45° field of view: 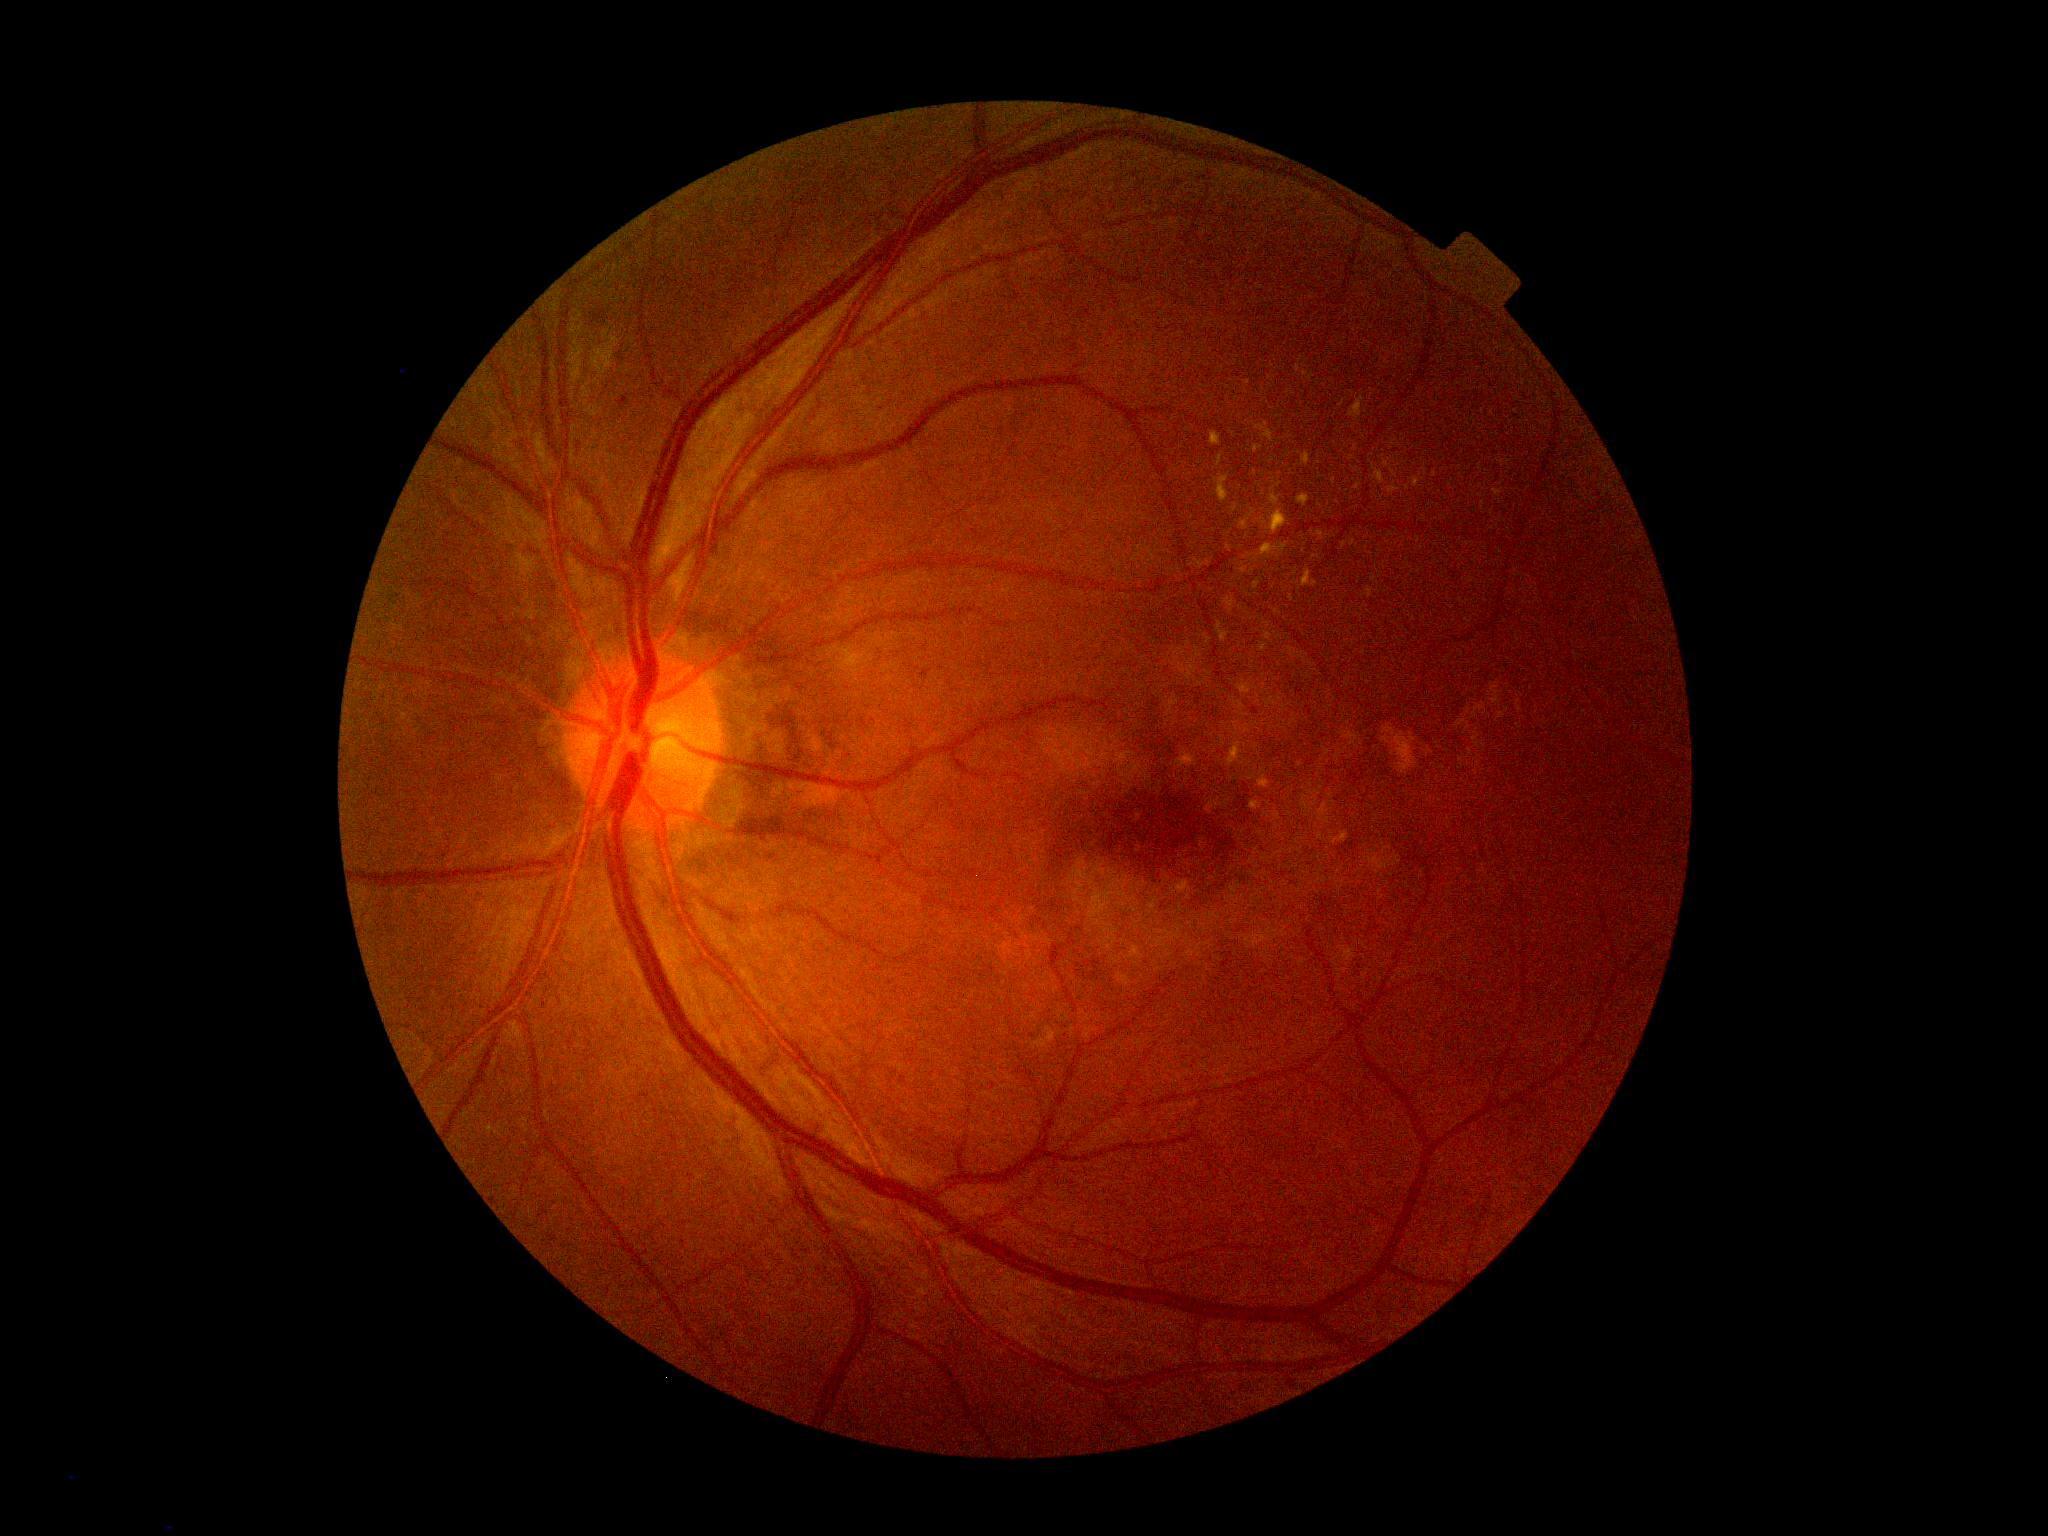
DR class: non-proliferative diabetic retinopathy.
Diabetic retinopathy severity is 2/4.